1932 x 1916 pixels:
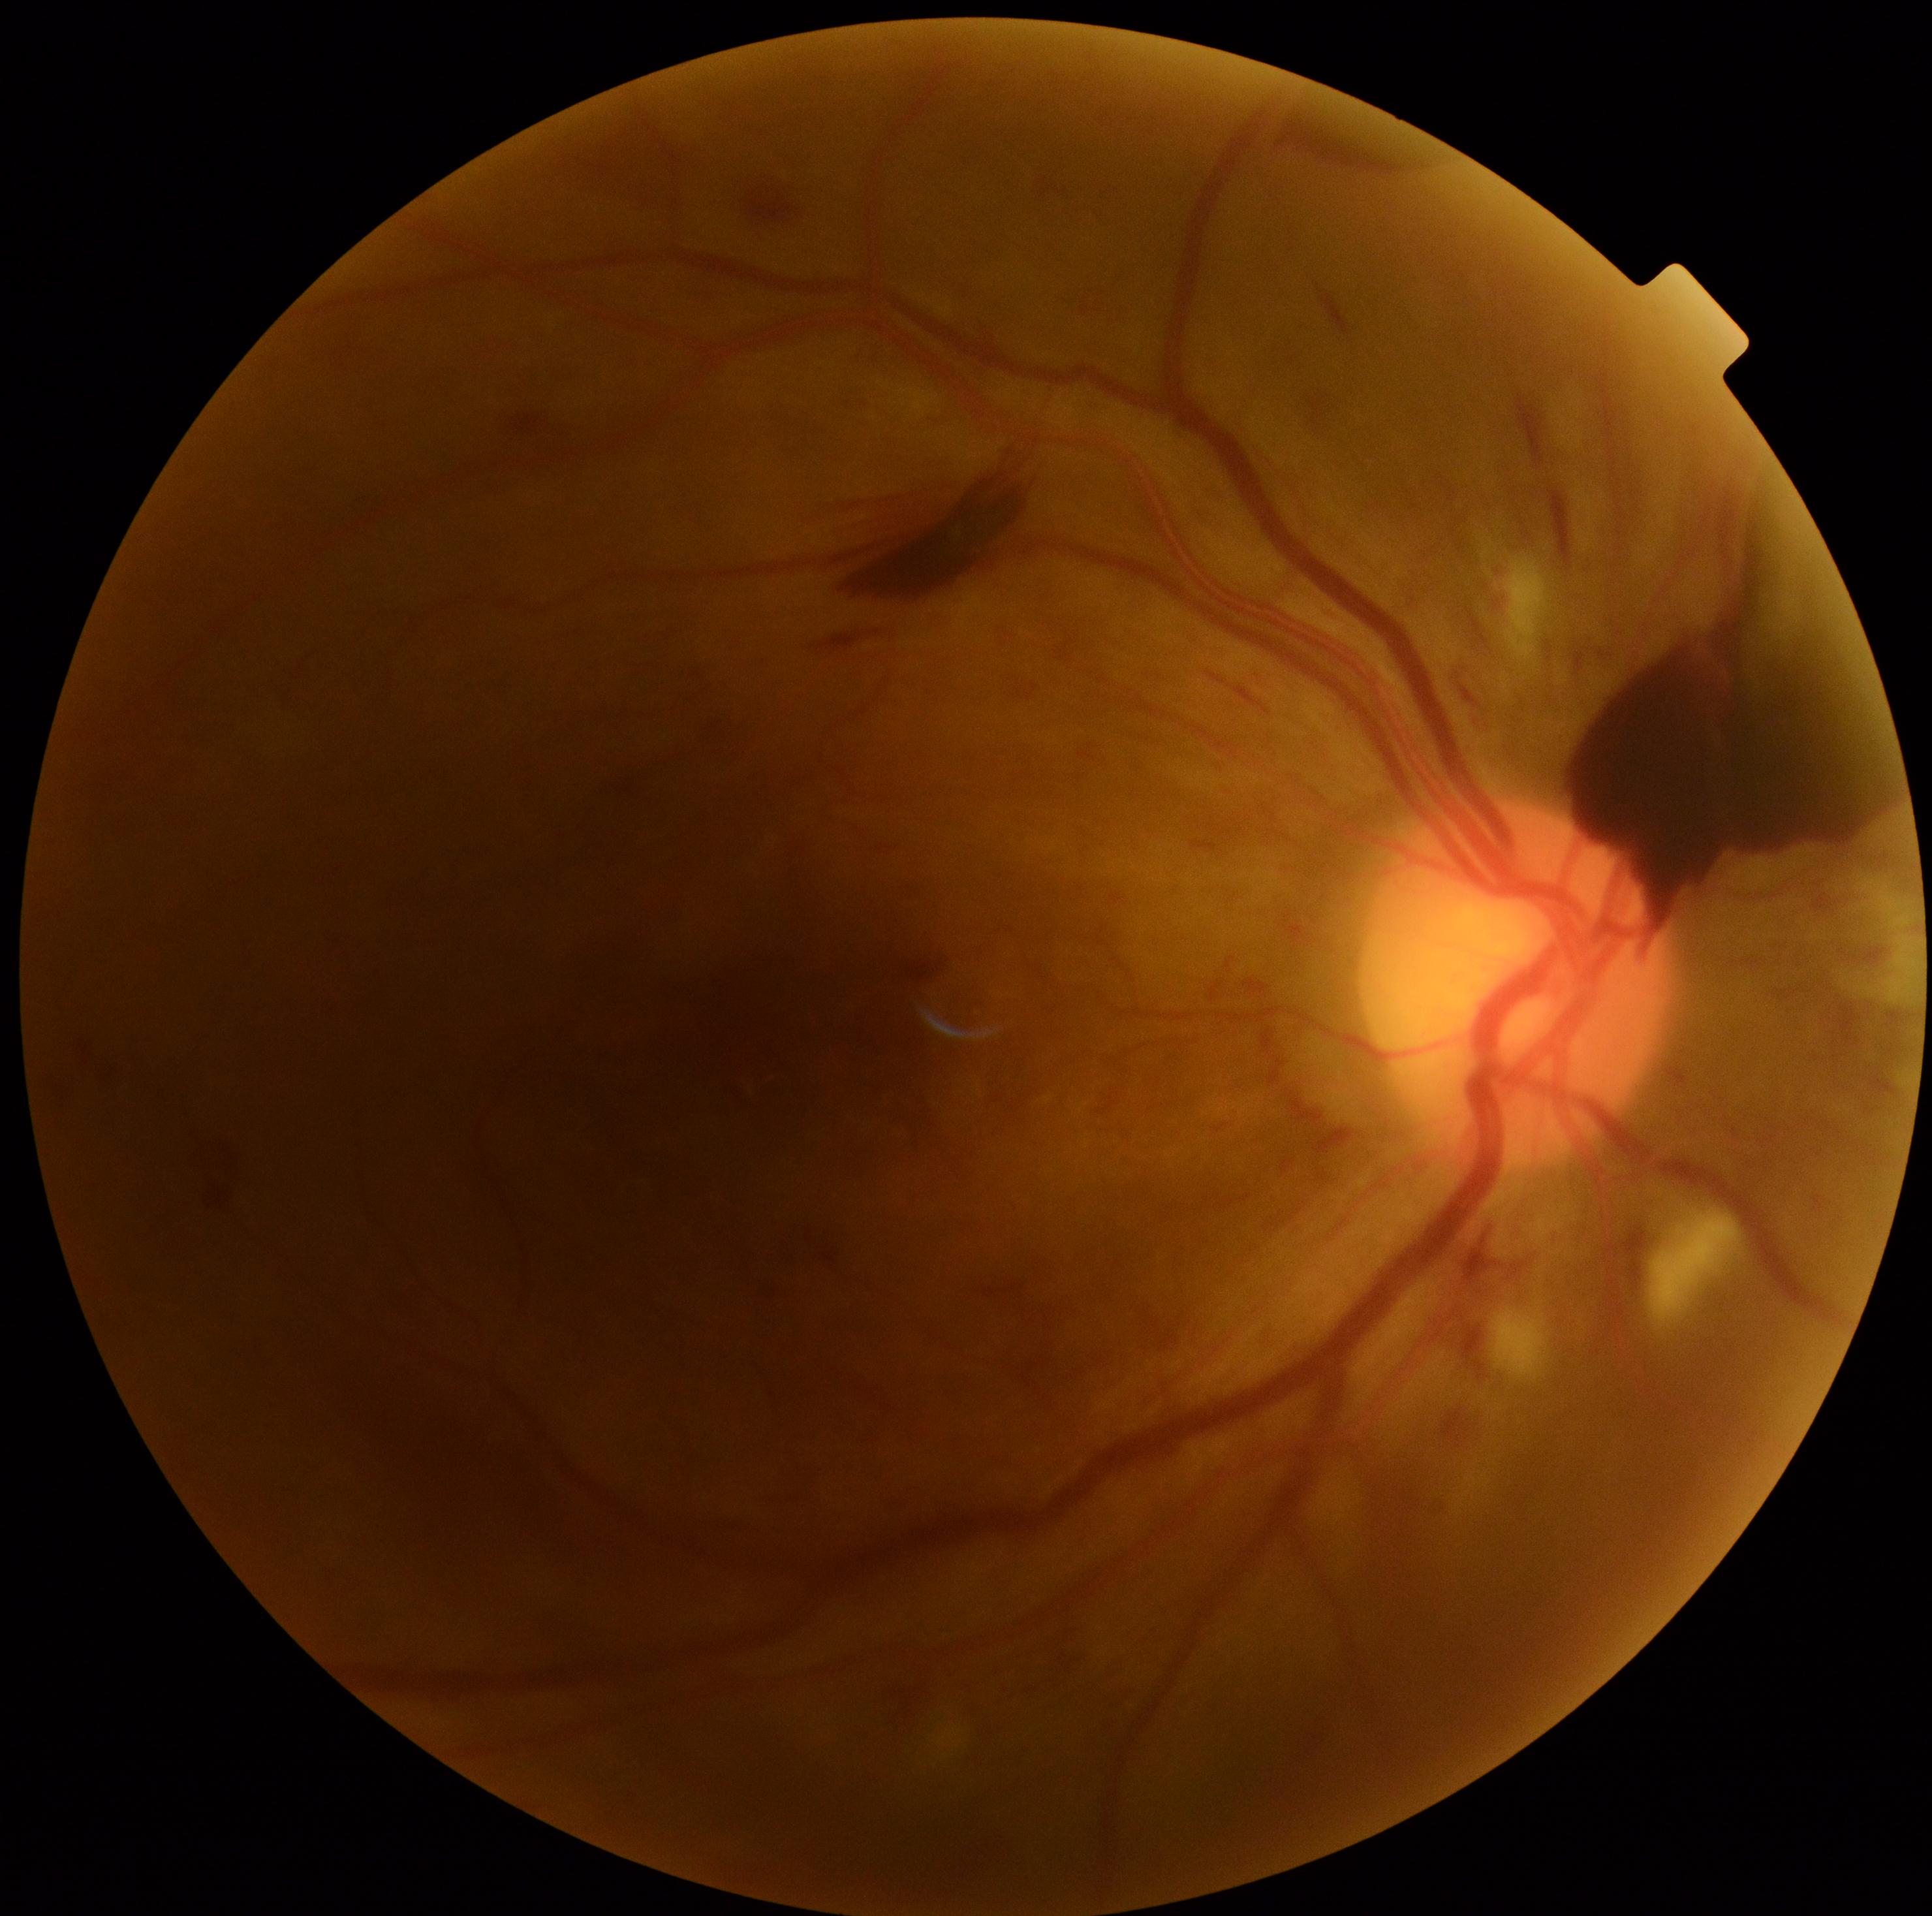 DR: grade 4 (PDR).
Disease class: proliferative diabetic retinopathy.